Acquired with a Topcon TRC · fundus image cropped to the optic disc:
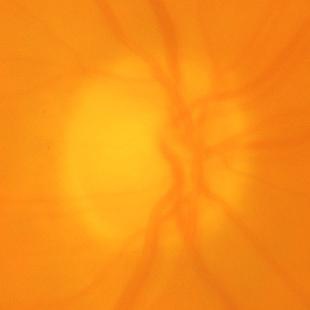

Assessment = glaucomatous damage to the optic nerve.